Captured with the Phoenix ICON (100° field of view); wide-field contact fundus photograph of an infant.
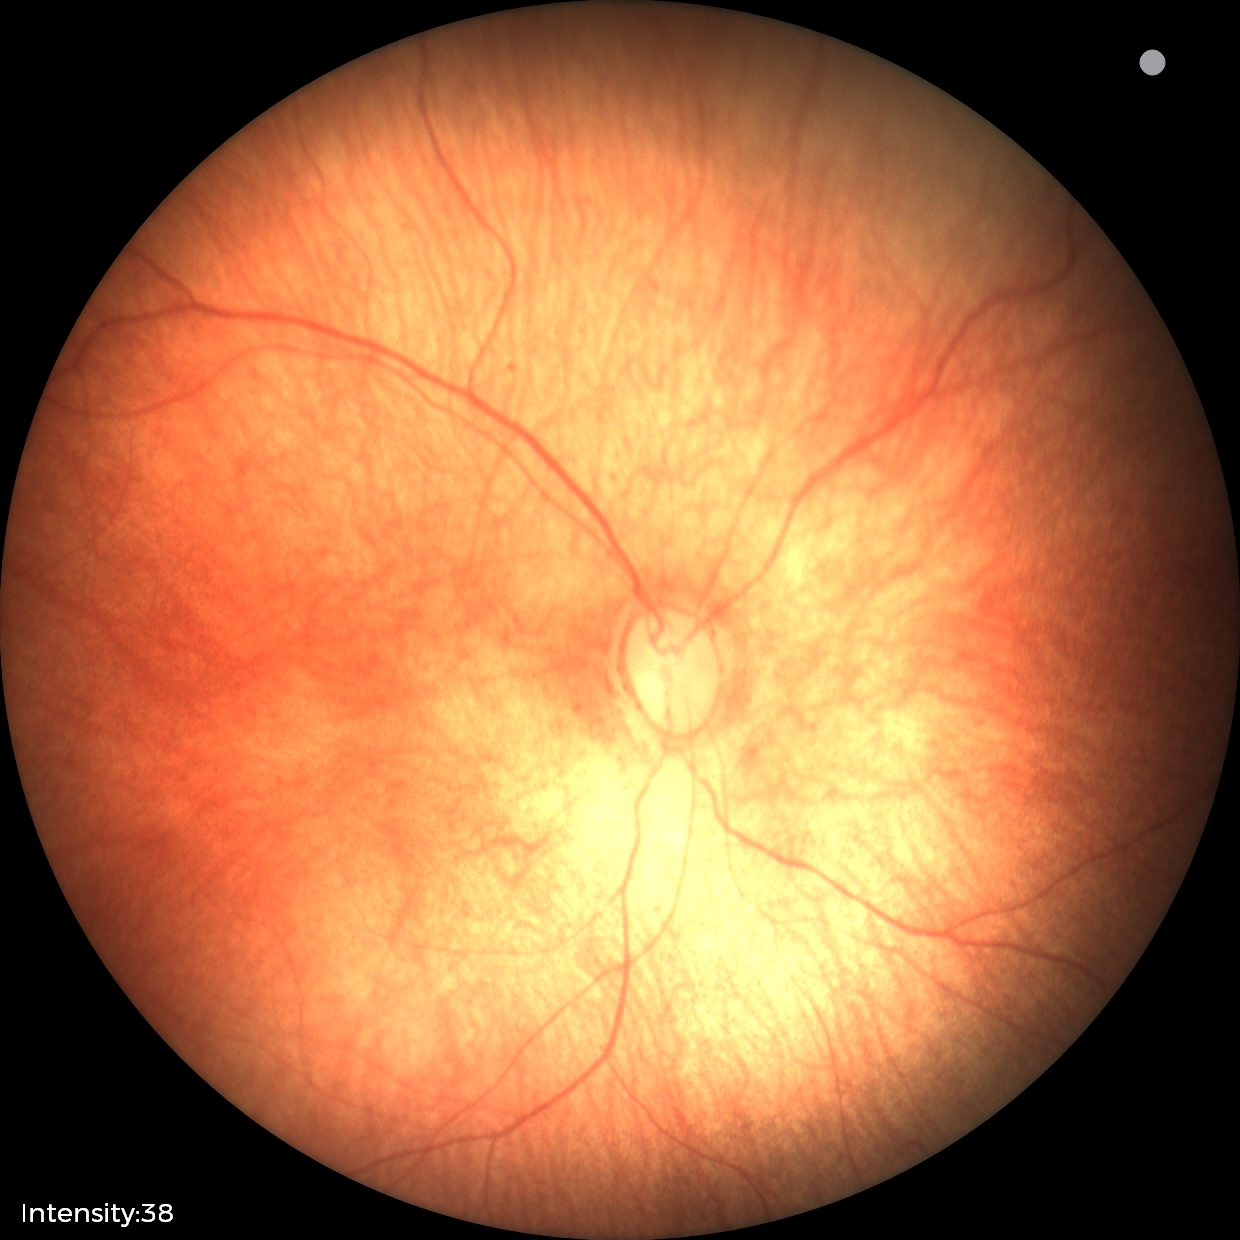 Physiological retinal appearance for postconceptual age.